Graded on the modified Davis scale
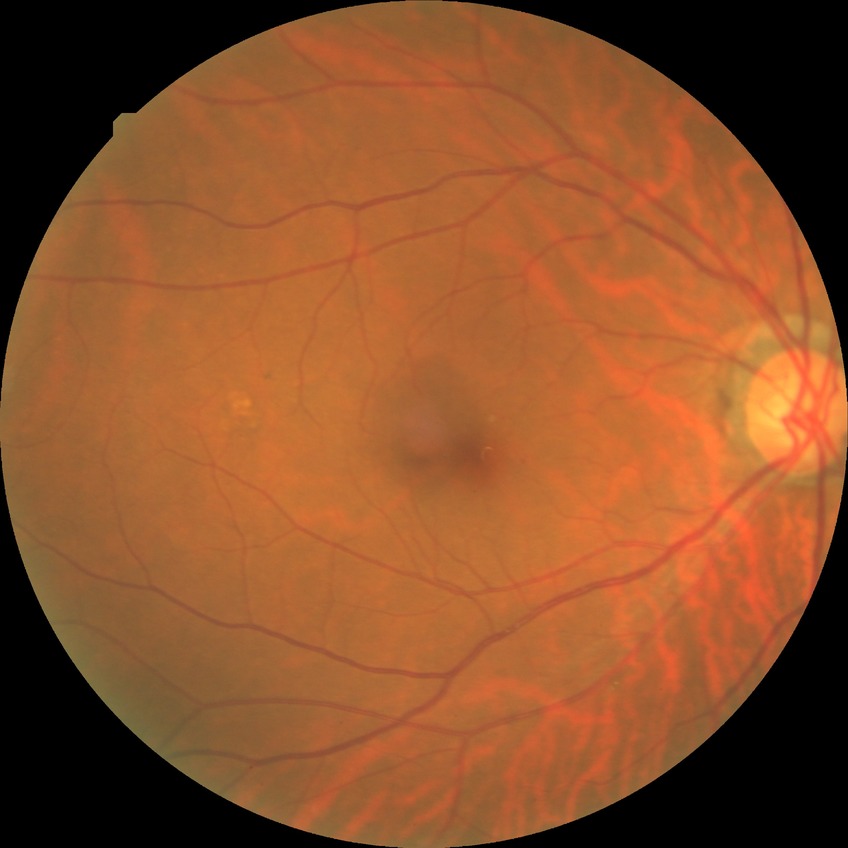

diabetic retinopathy (DR) = NDR (no diabetic retinopathy)